Captured after pupil dilation; macula at the center of the field; CFP; image size 2361x1568
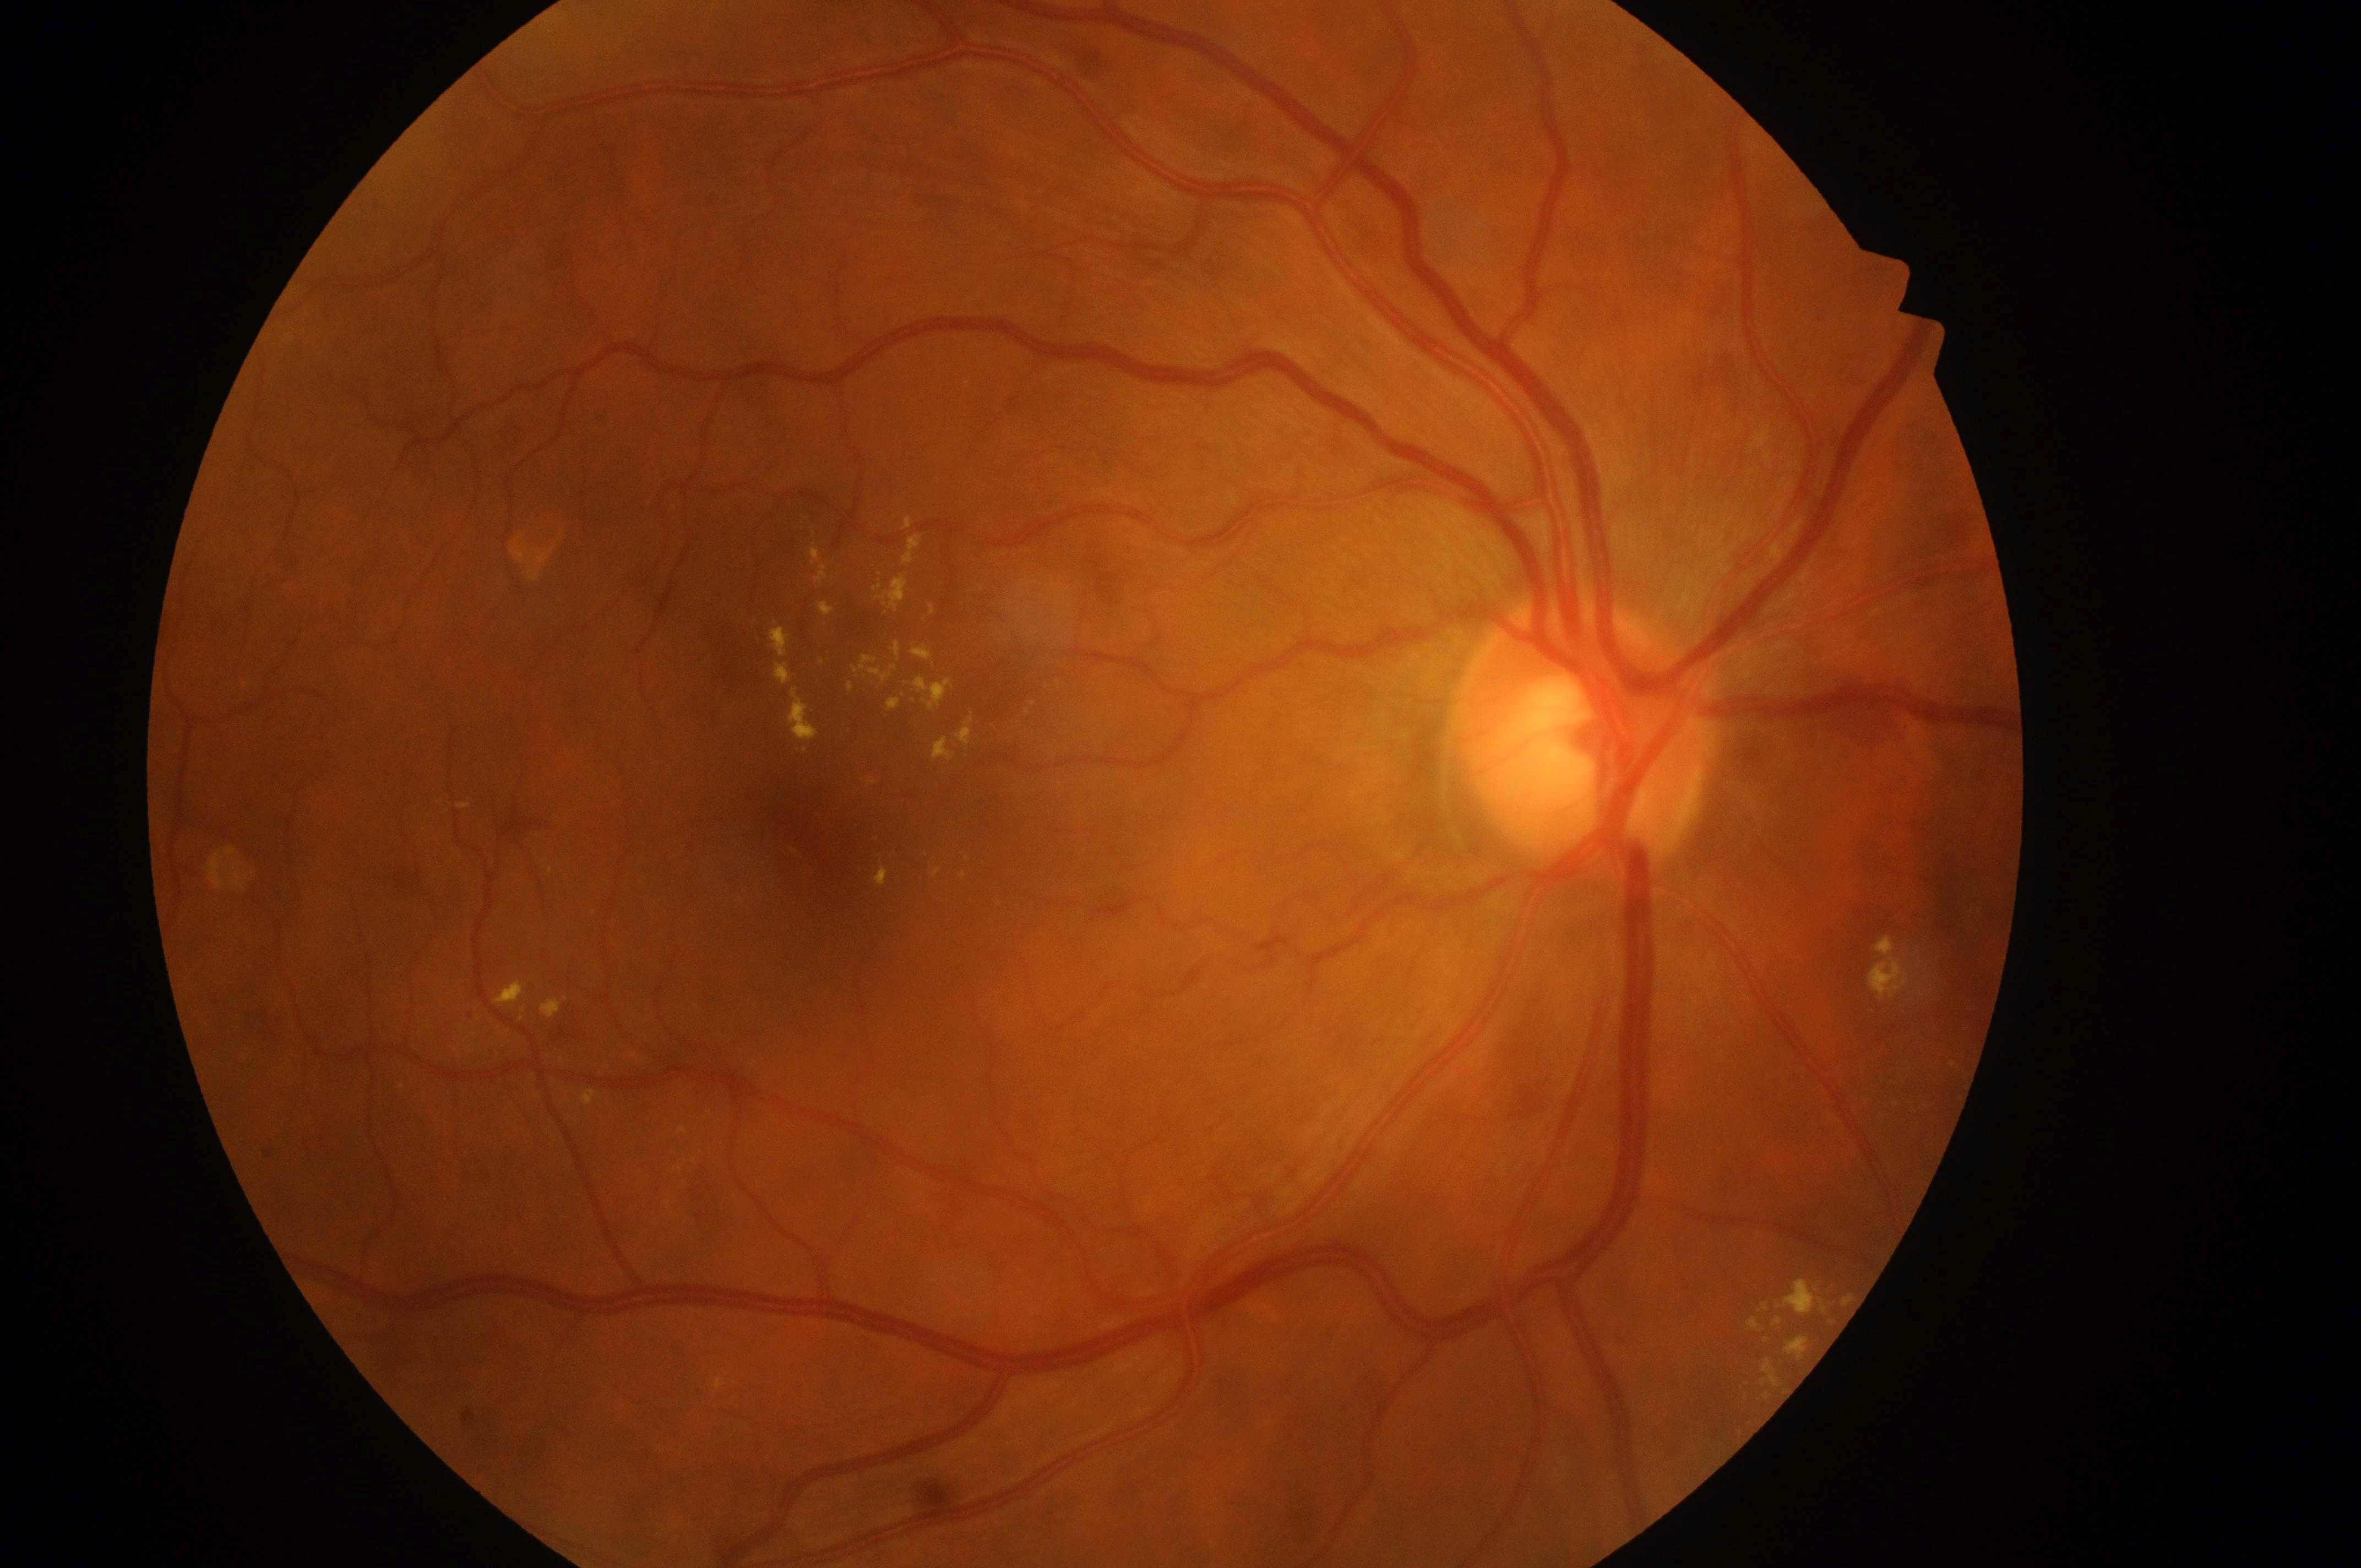

fovea: 823px, 839px
laterality: right
retinopathy: moderate NPDR (grade 2)
macular edema risk: high risk (grade 2)
disc center: 1580px, 744px